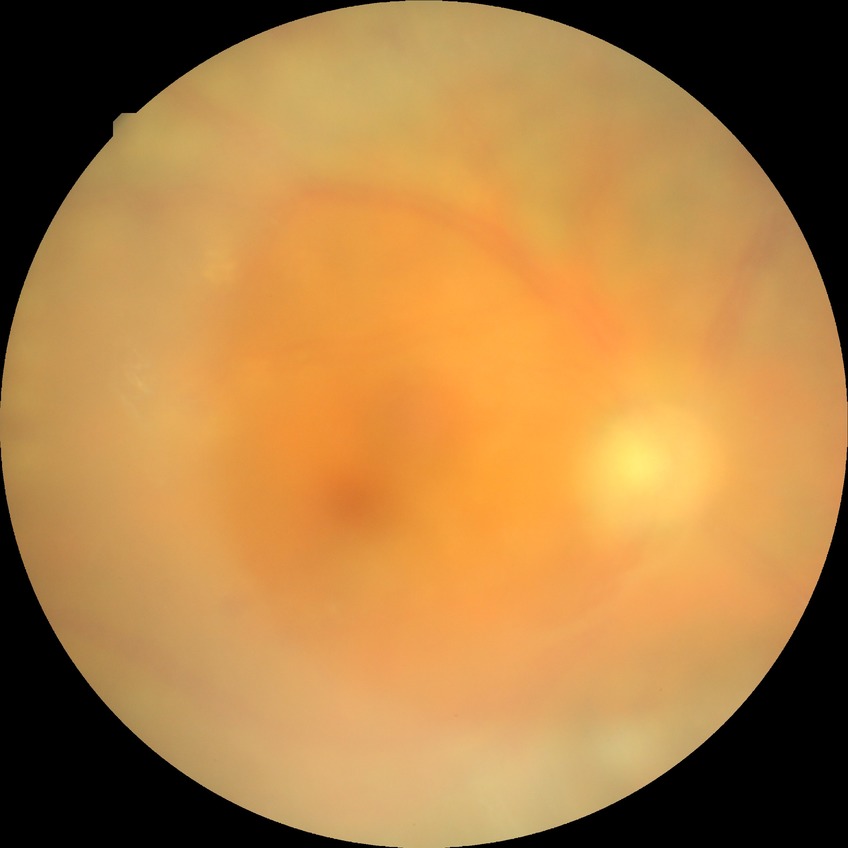 diabetic retinopathy (DR): proliferative diabetic retinopathy (PDR).